Centered on the macula, captured after pupil dilation
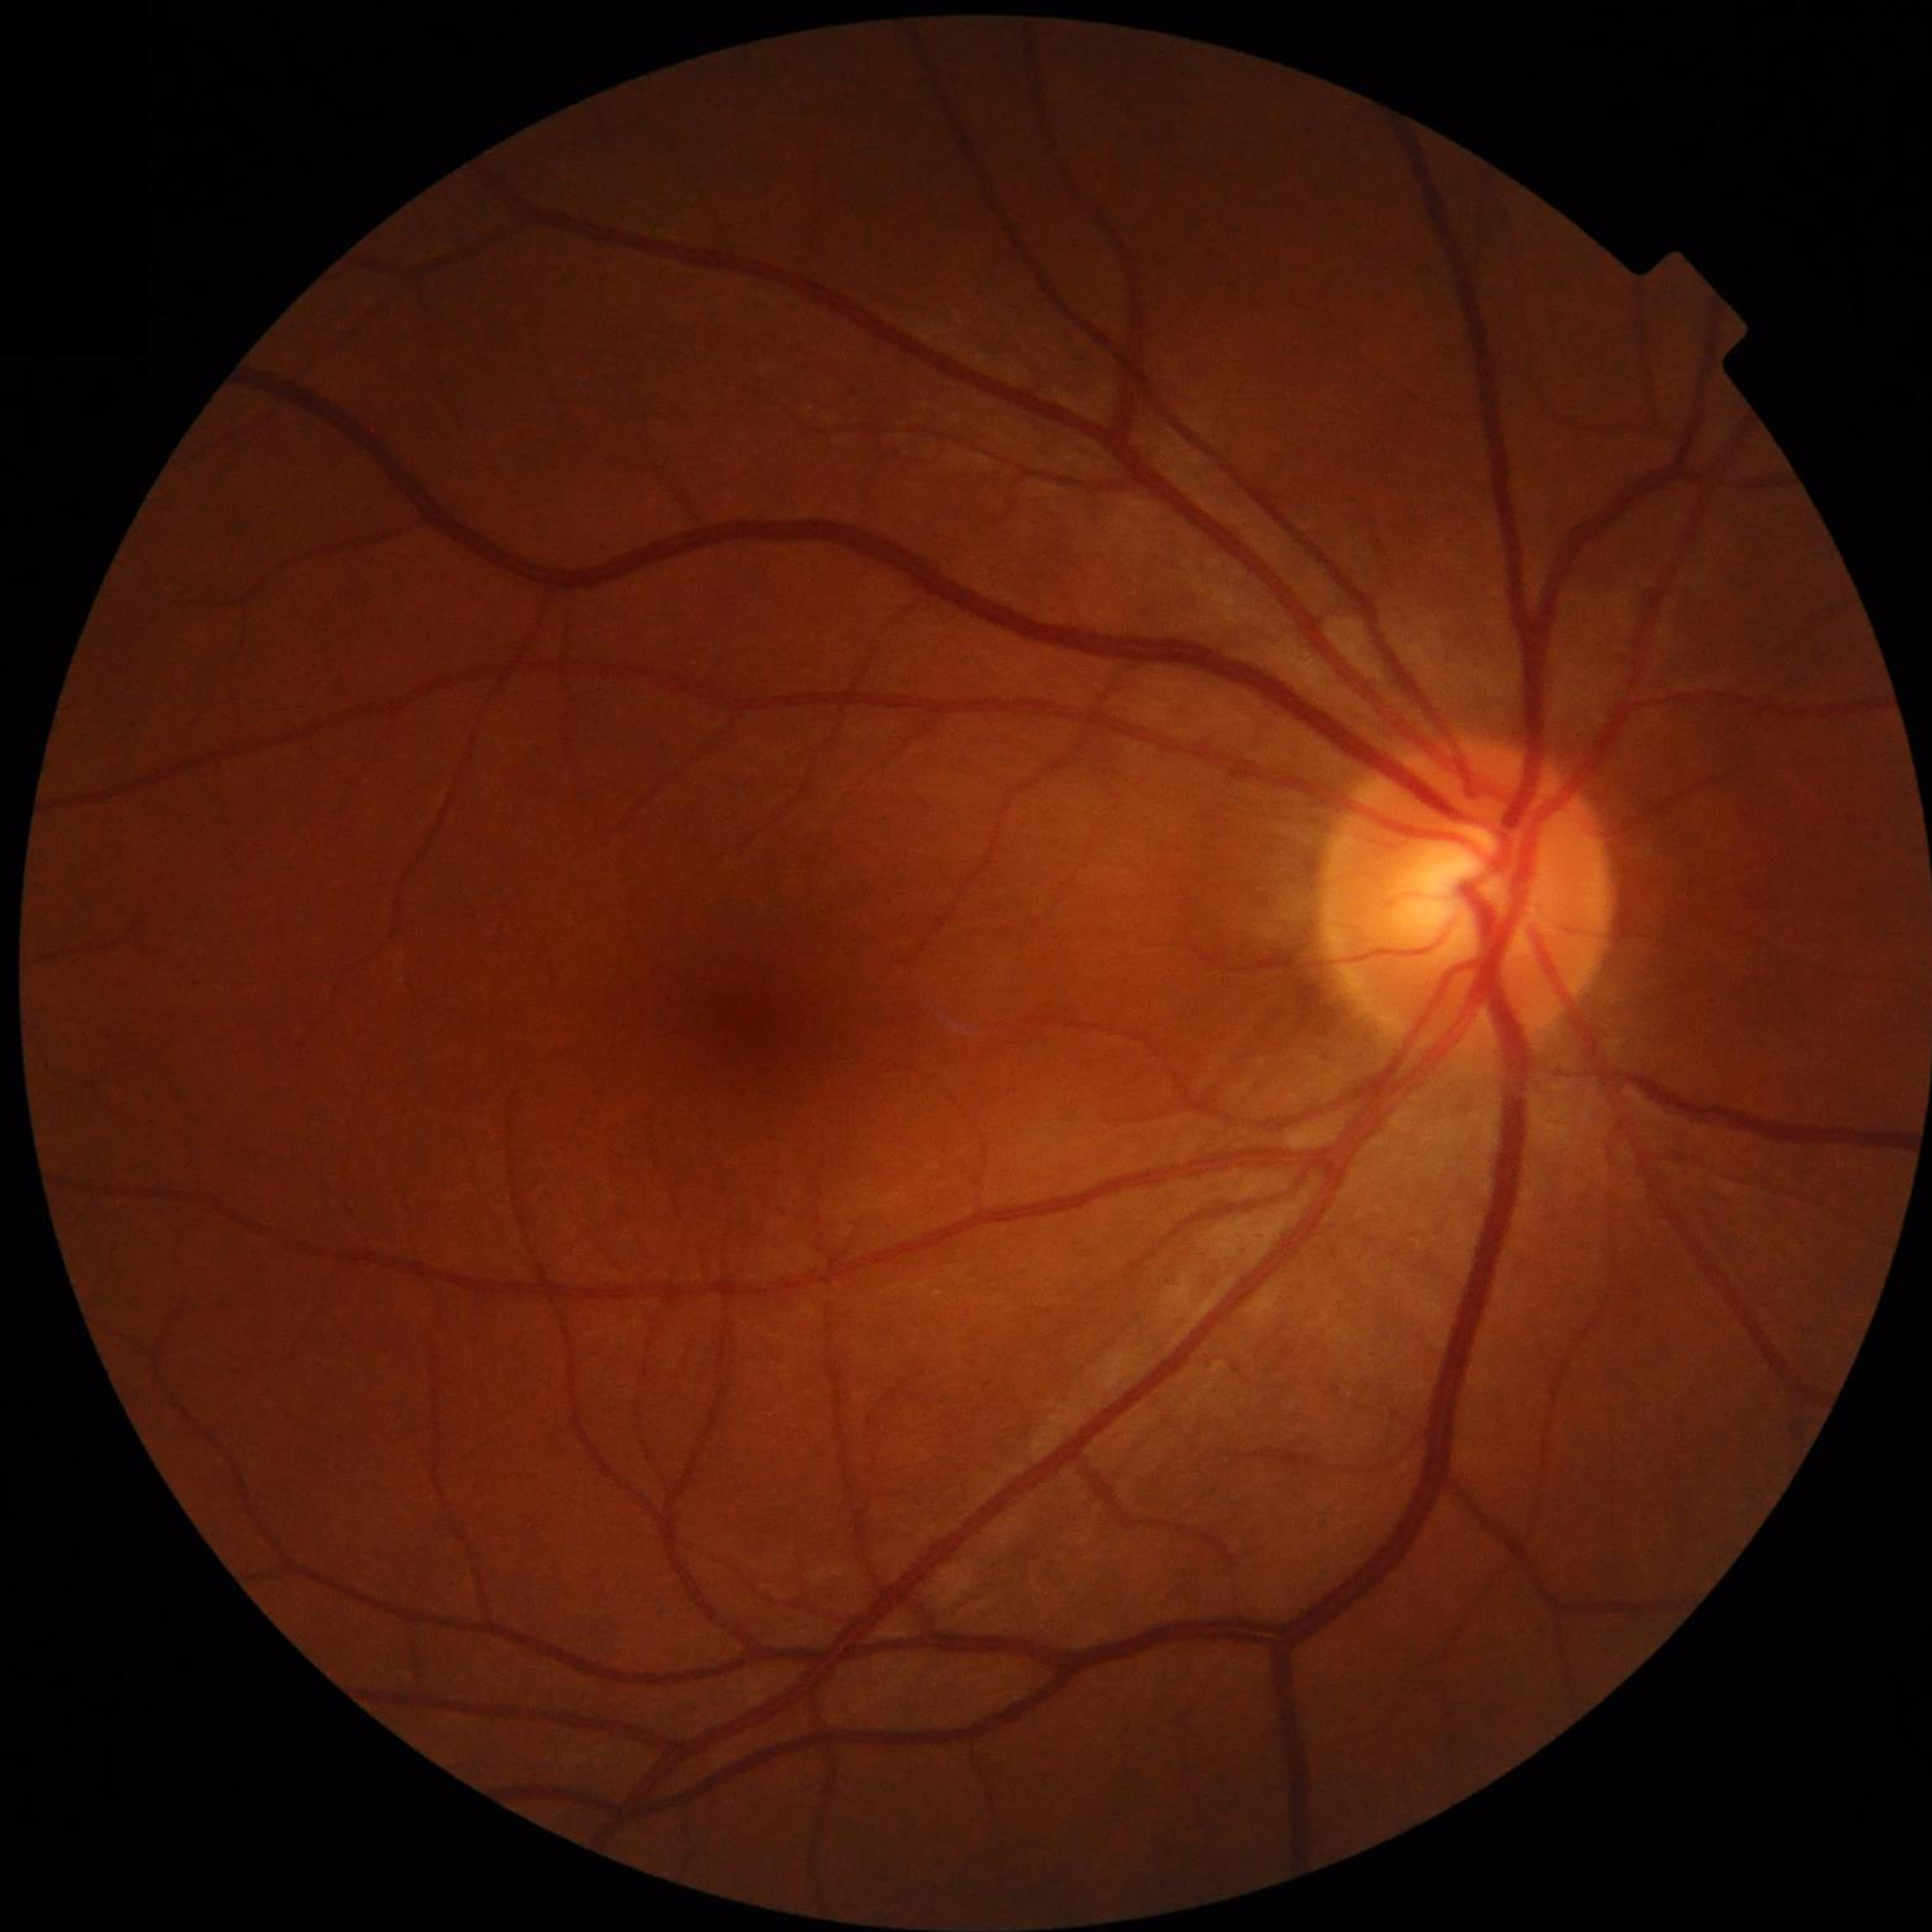

Impression: no AMD, DR, or glaucoma
Automated quality assessment: good